DR severity per modified Davis staging, CFP: 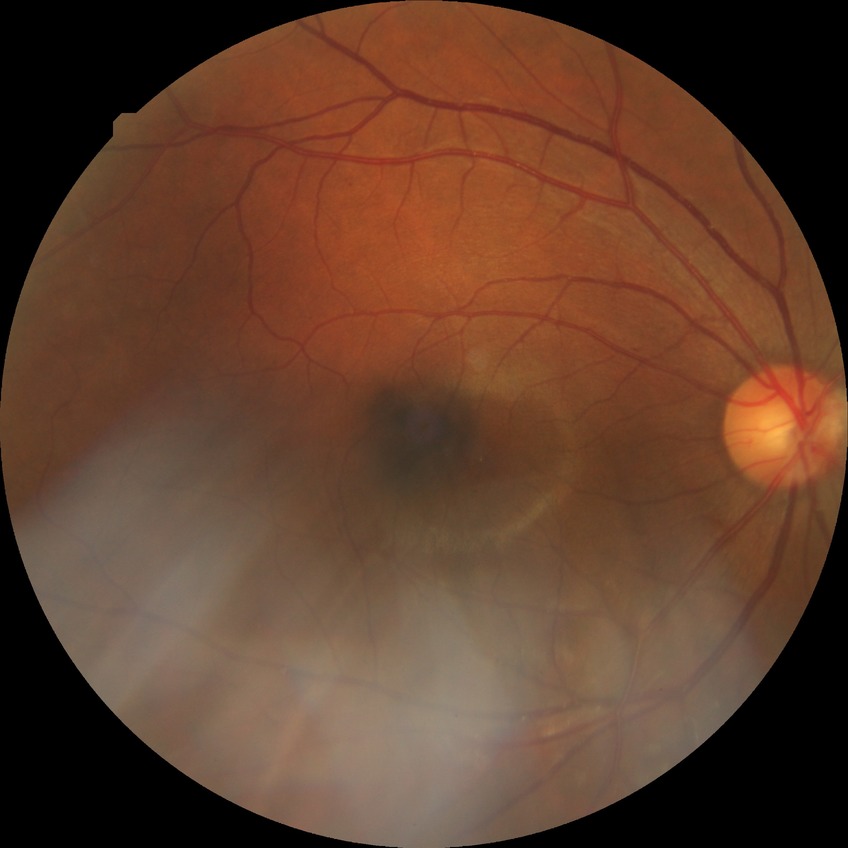 Davis grading is simple diabetic retinopathy.